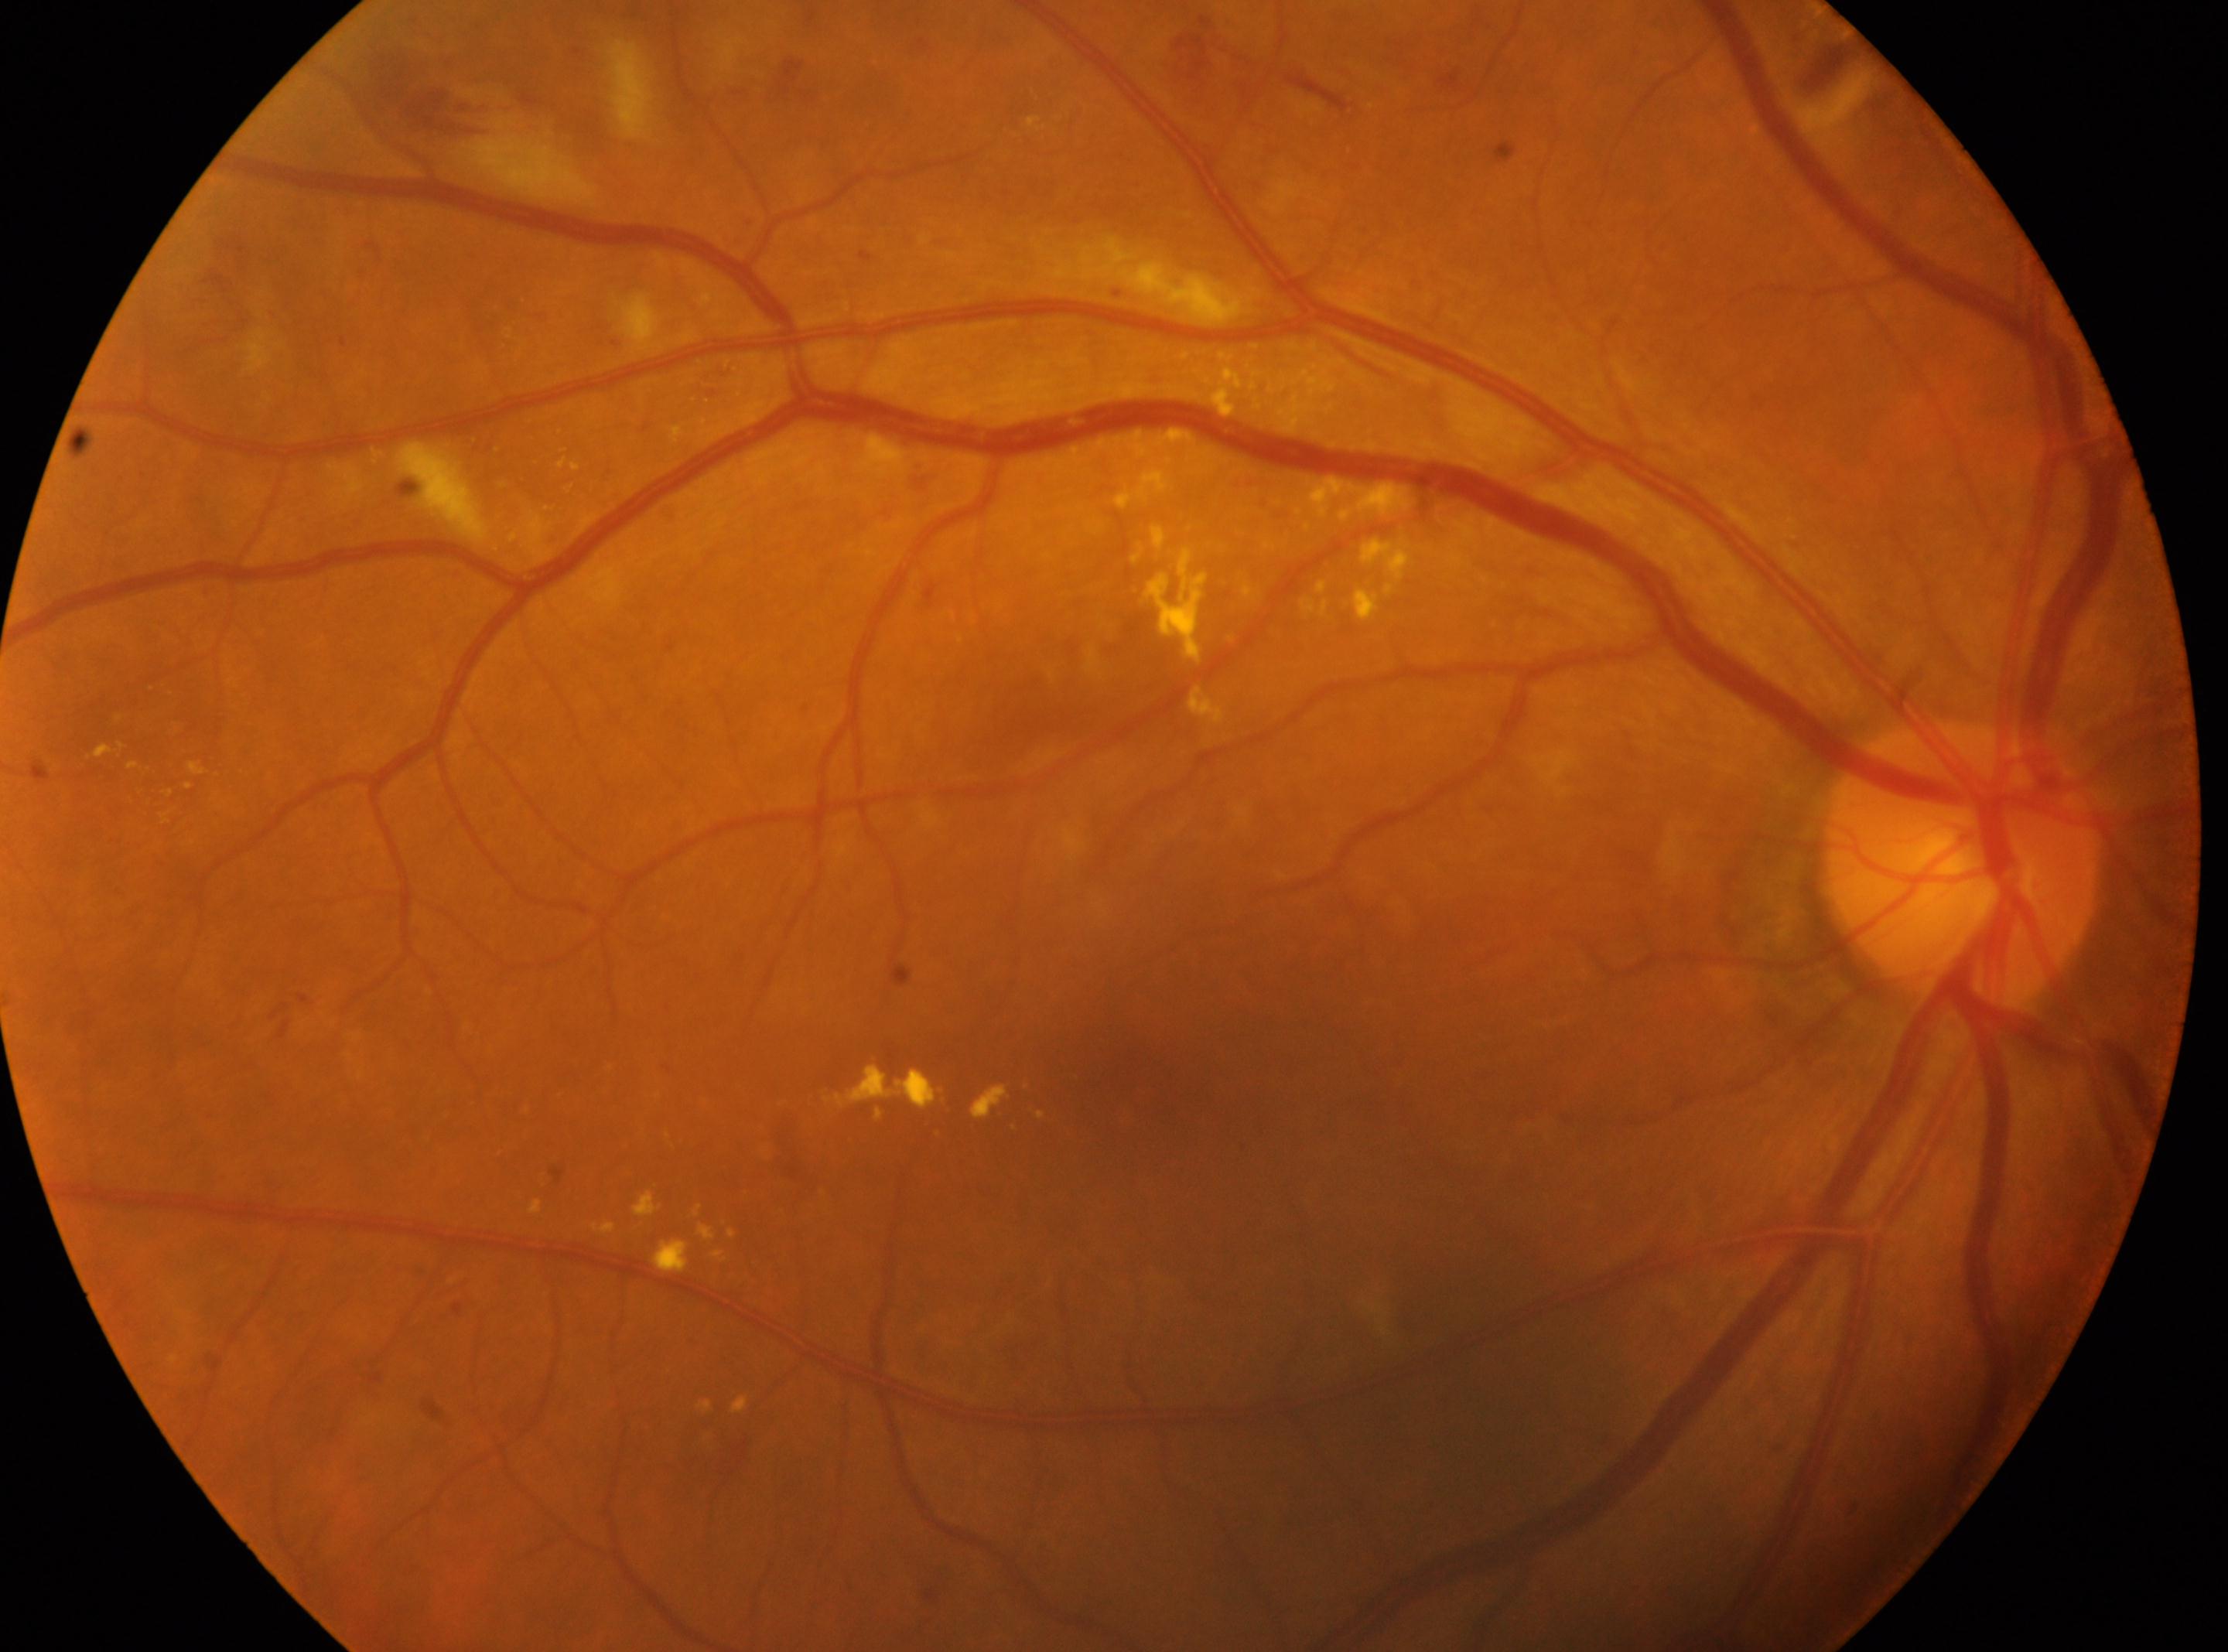

DR class: non-proliferative diabetic retinopathy. Imaged eye: OD. Fovea: (1119,1078). Optic disc center located at (1960,865). Diabetic retinopathy (DR) is moderate non-proliferative diabetic retinopathy (grade 2).